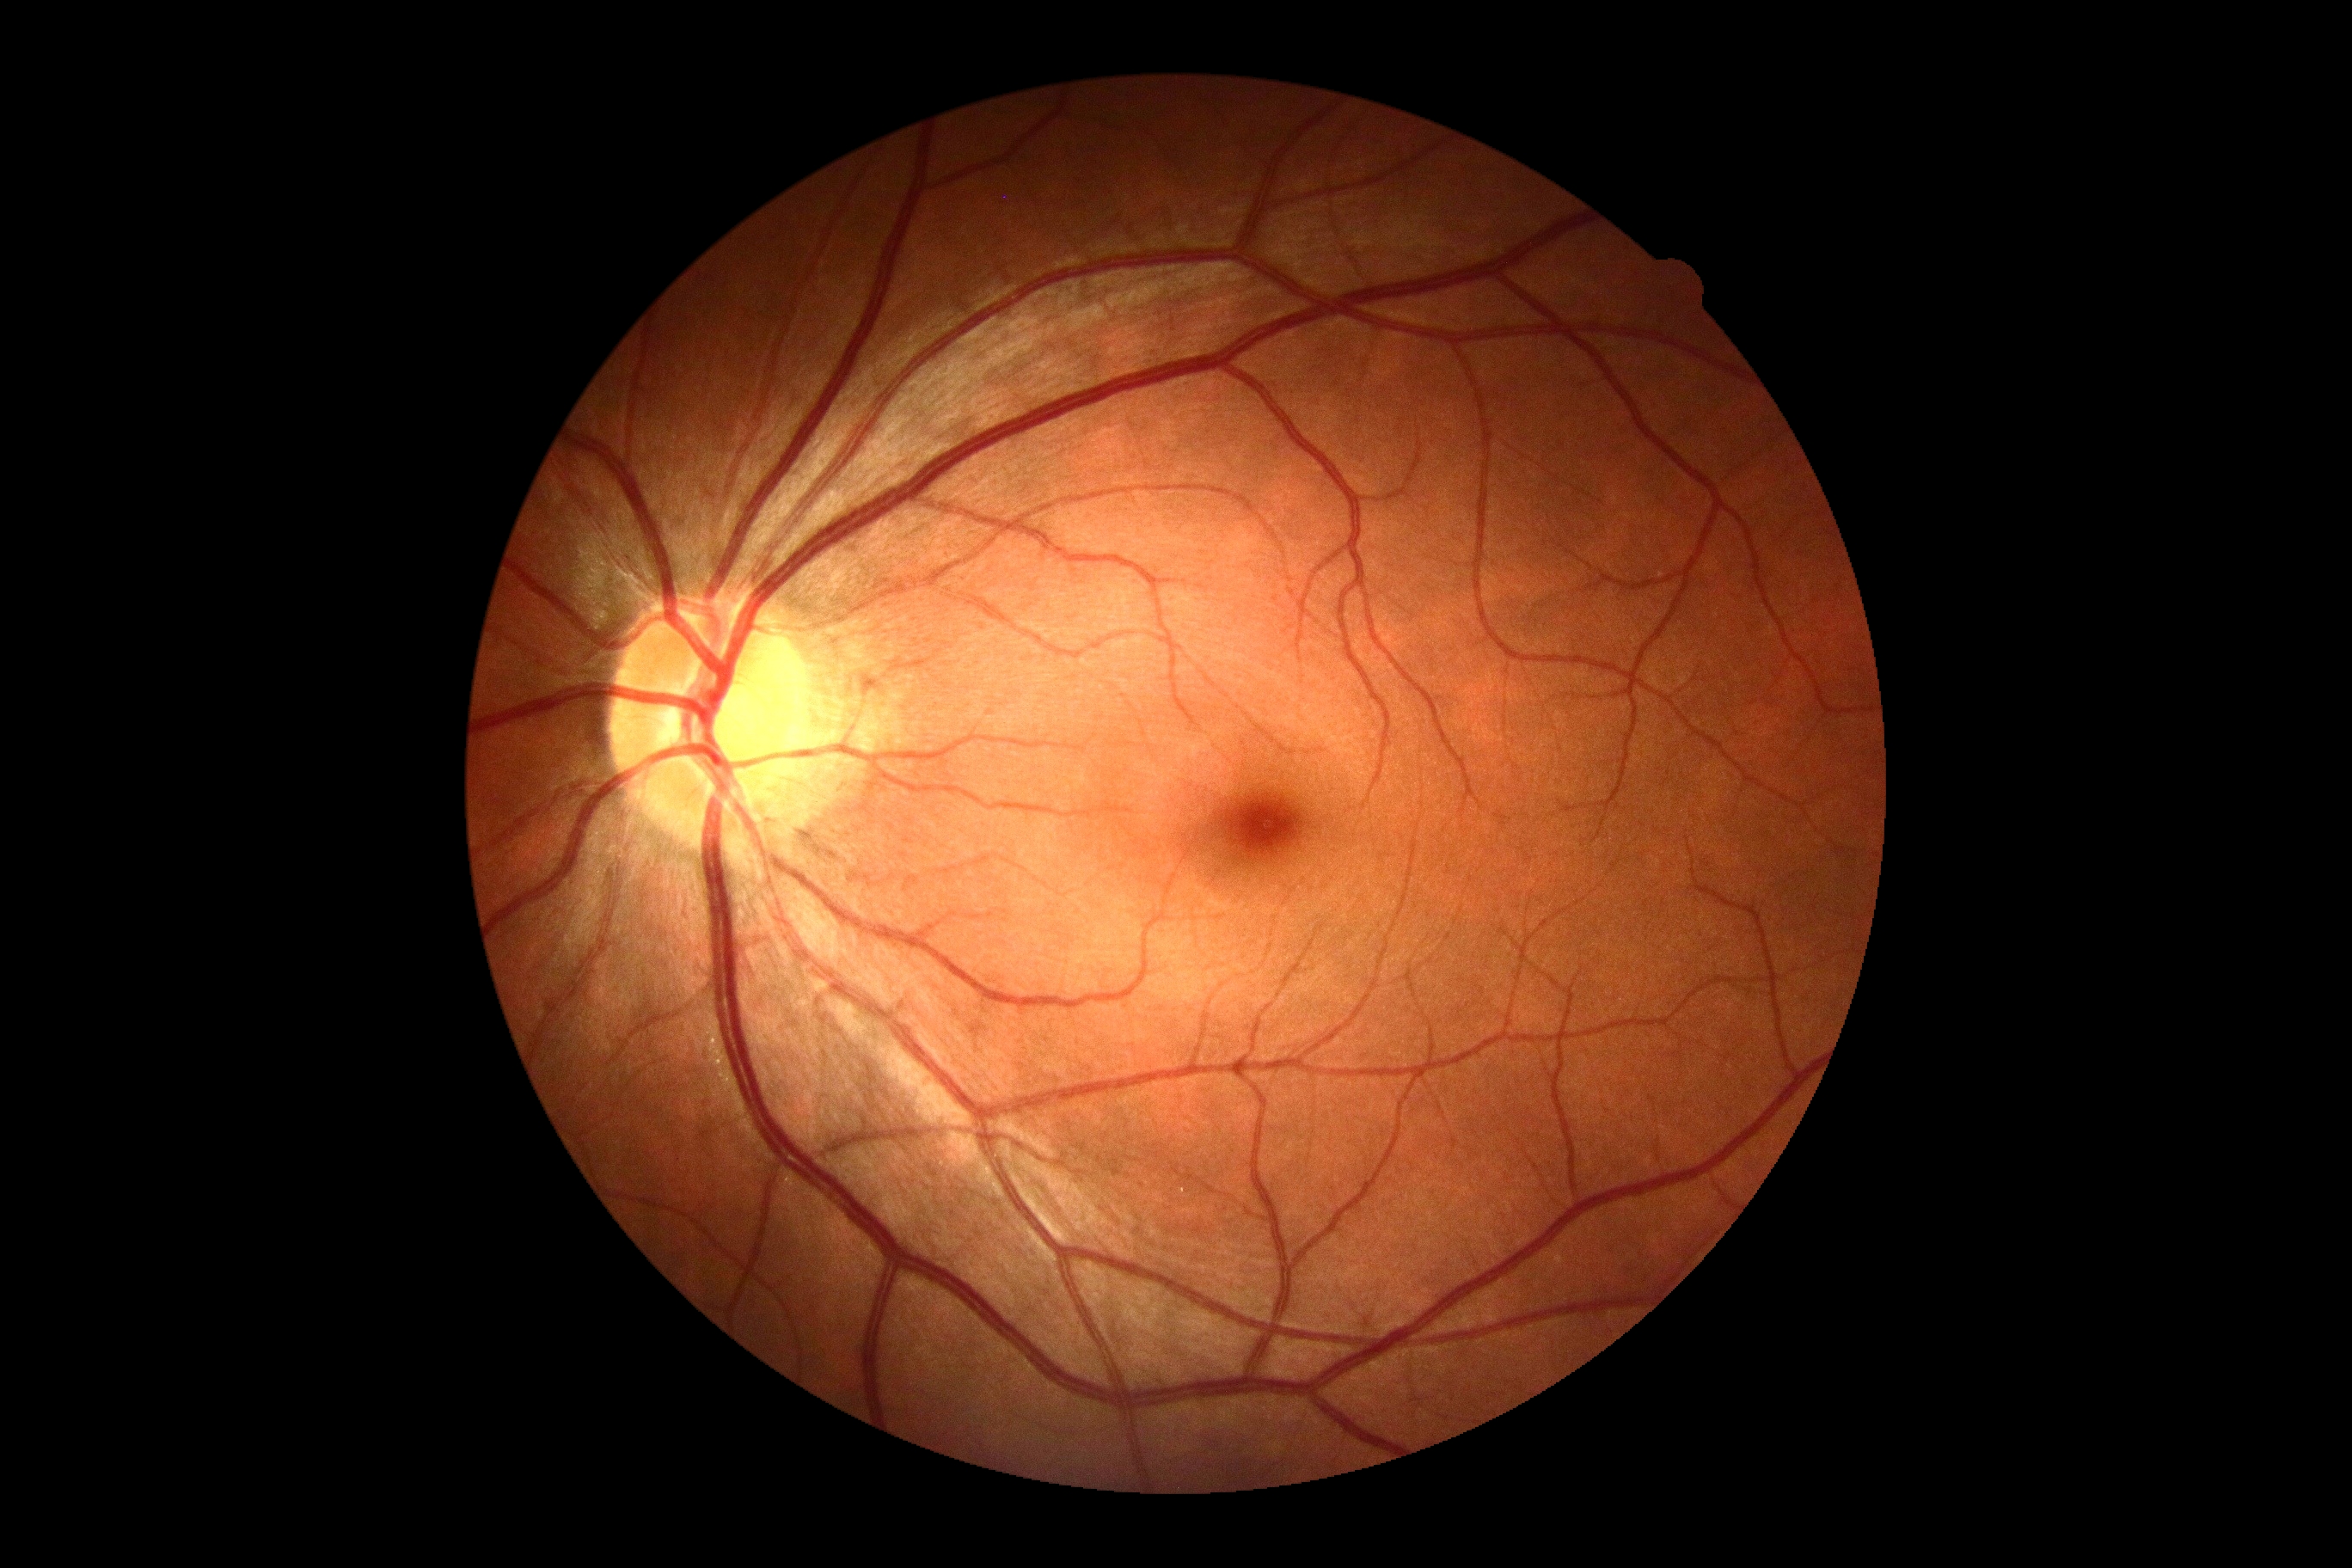 {"dr_grade": "0/4 — no visible signs of diabetic retinopathy"}